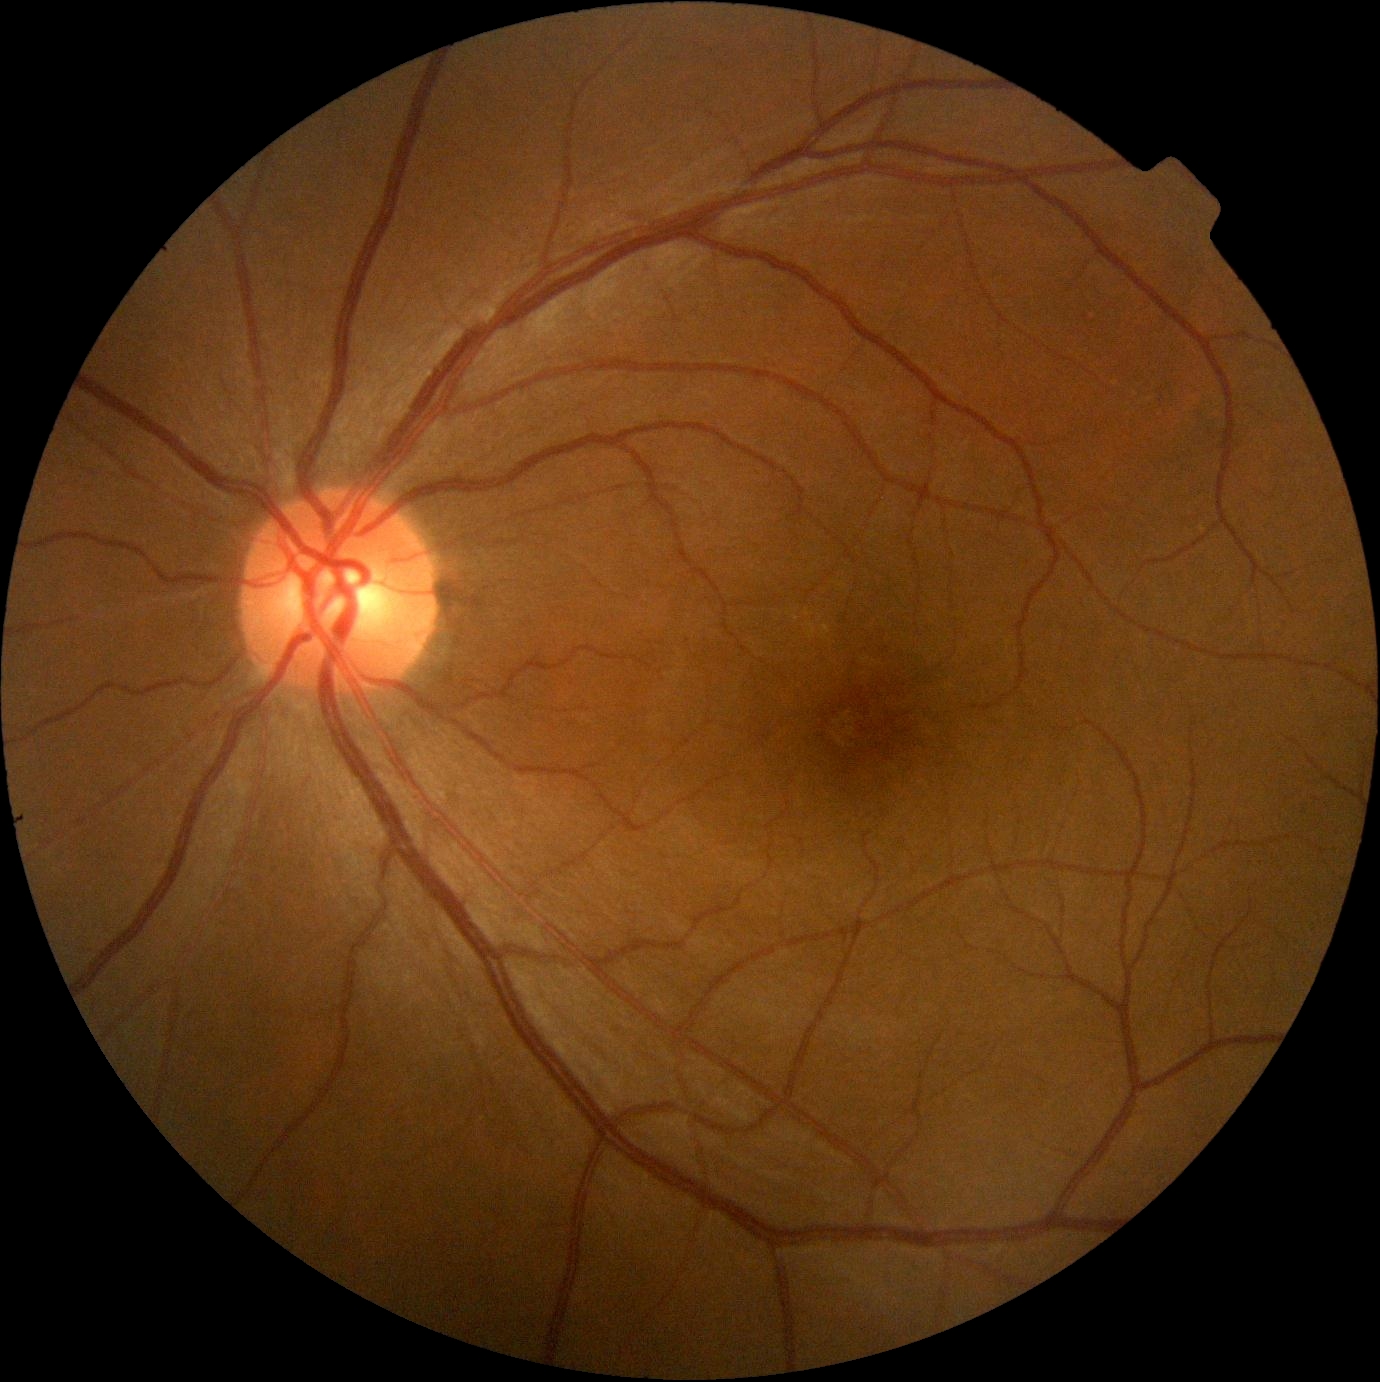
{"dr_grade": "no apparent diabetic retinopathy (0) — no visible signs of diabetic retinopathy"}